Retinal fundus photograph: 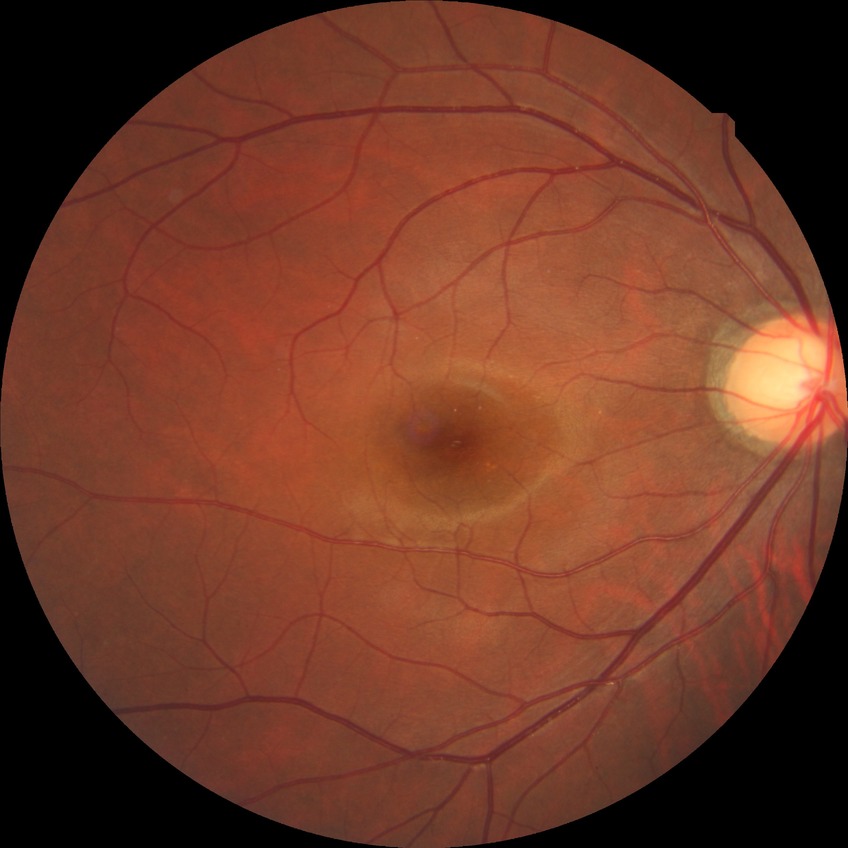 Assessment:
* DR class: non-proliferative diabetic retinopathy
* diabetic retinopathy (DR): SDR (simple diabetic retinopathy)